1659x2212px: 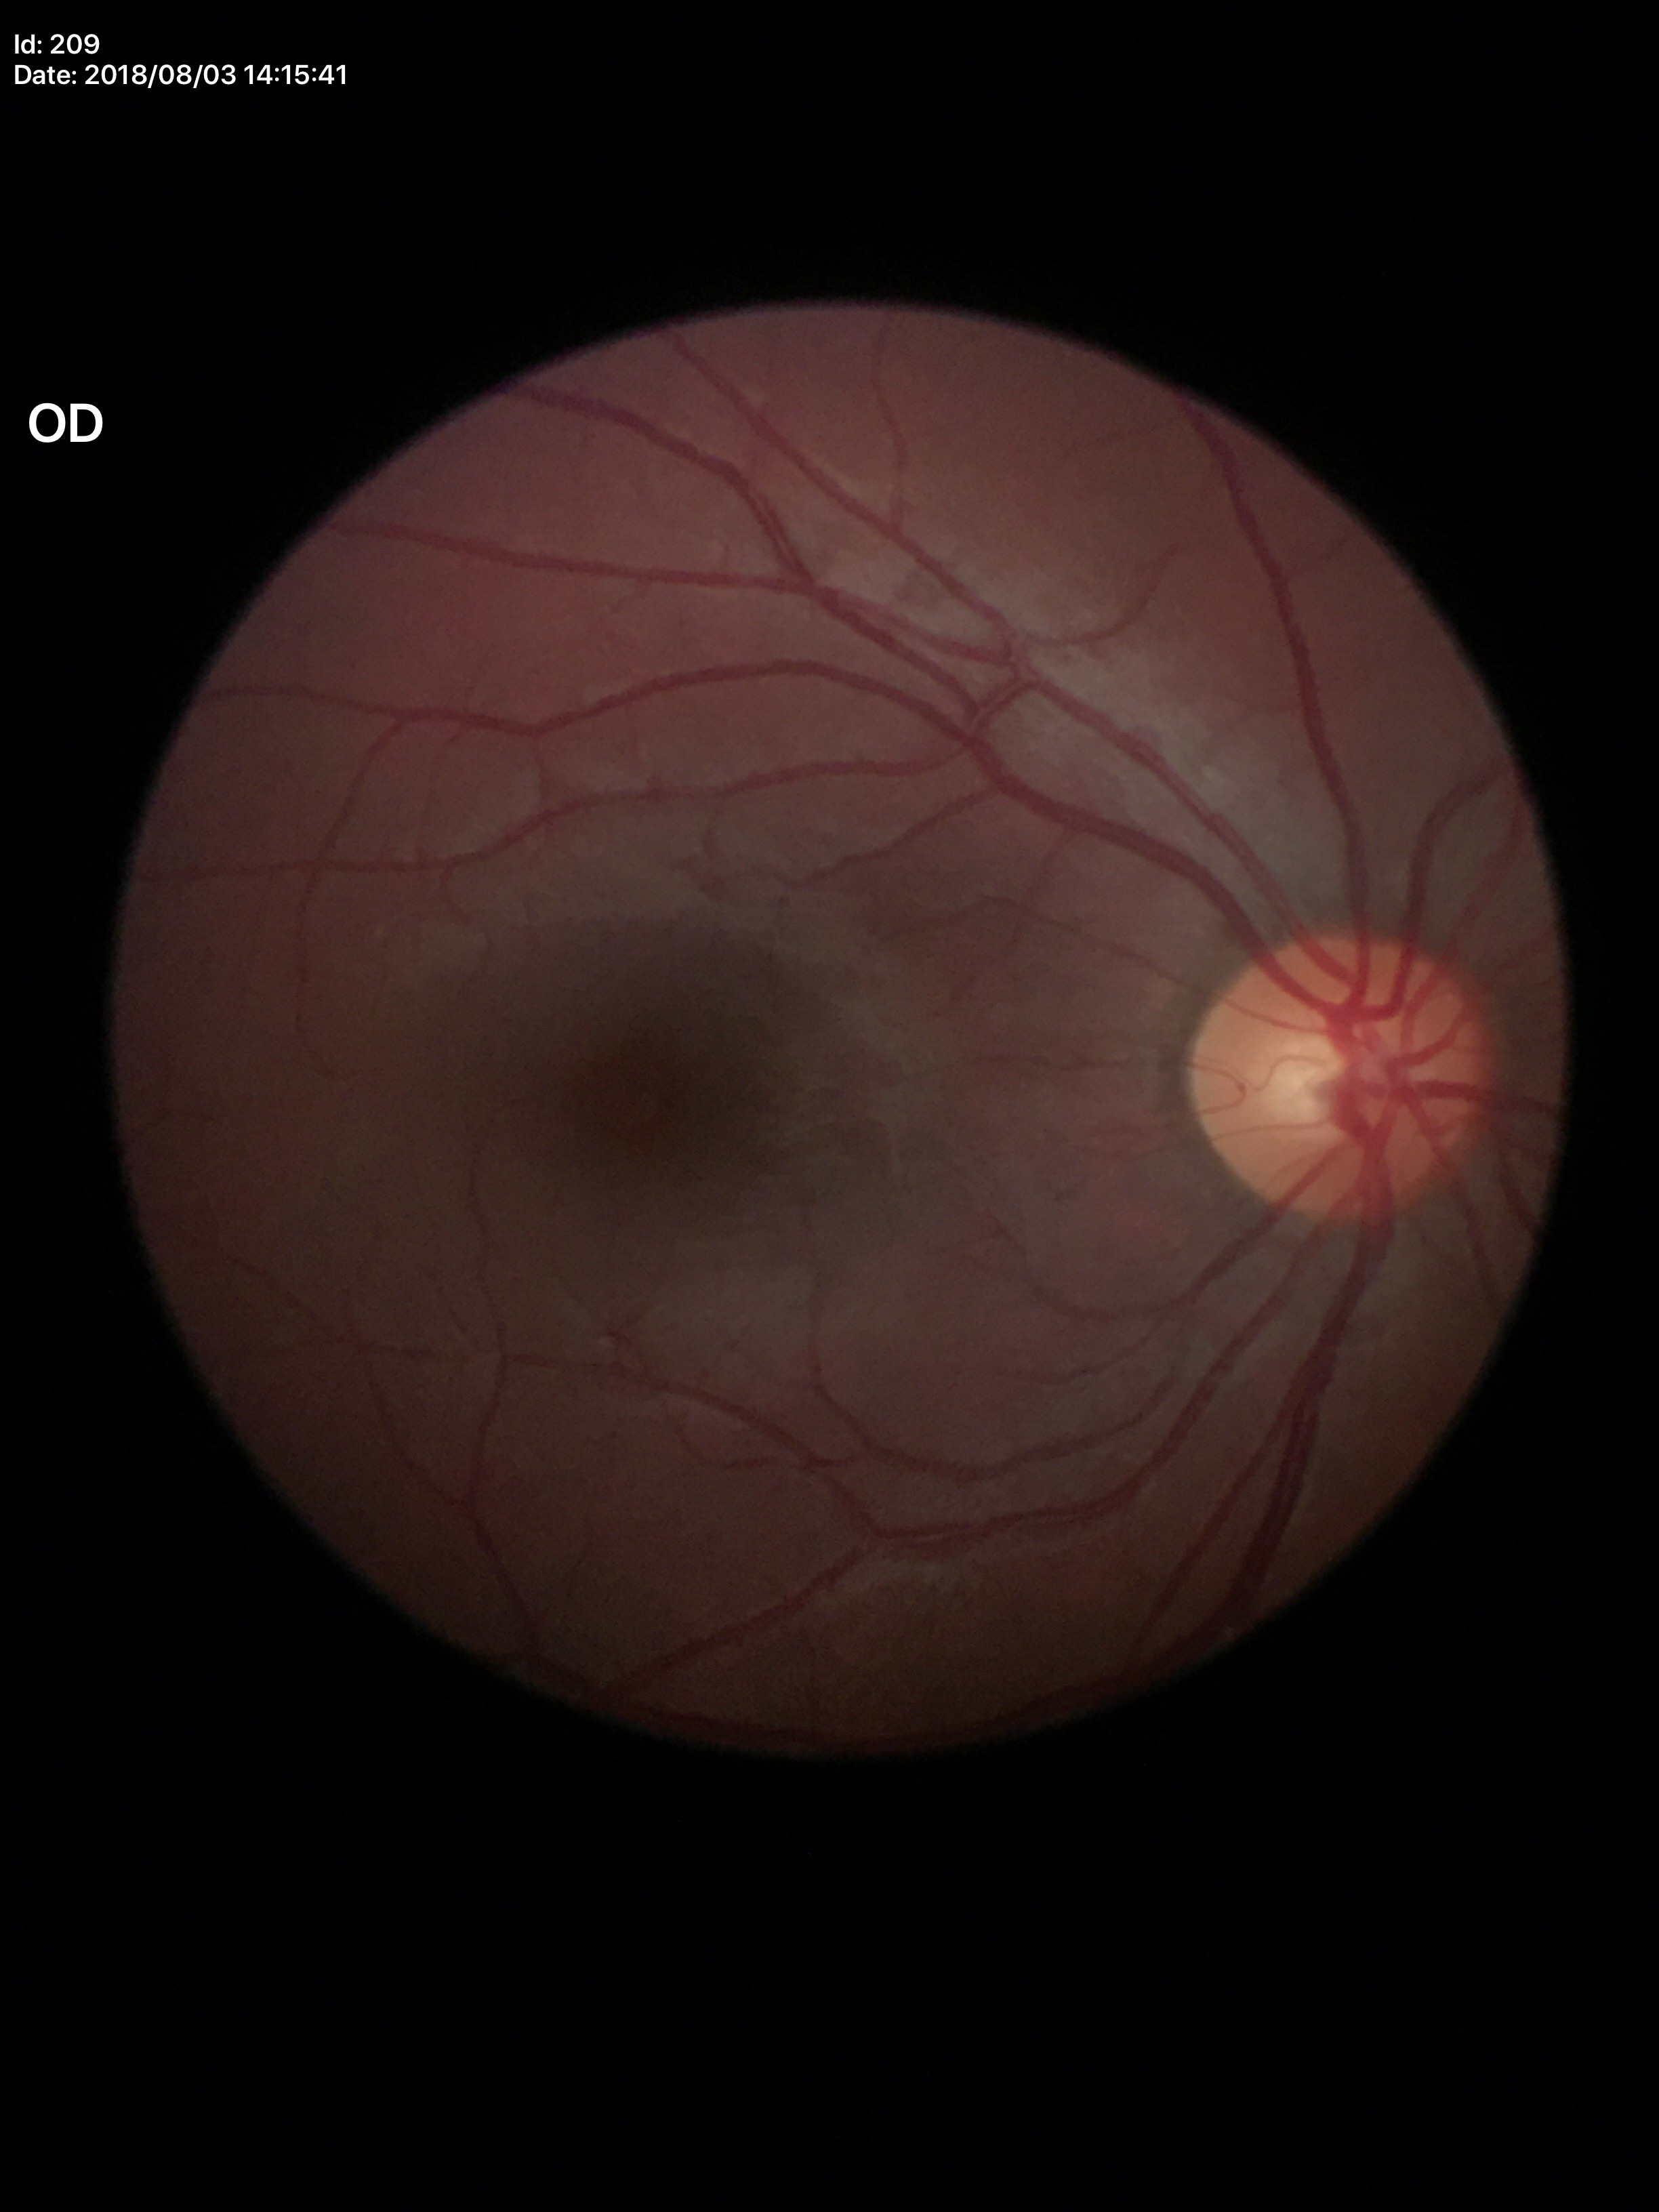

{"glaucoma_decision": "no suspicious findings", "hcdr": "0.51", "vcdr": "0.46"}